FOV: 45 degrees · modified Davis grading · NIDEK AFC-230 fundus camera
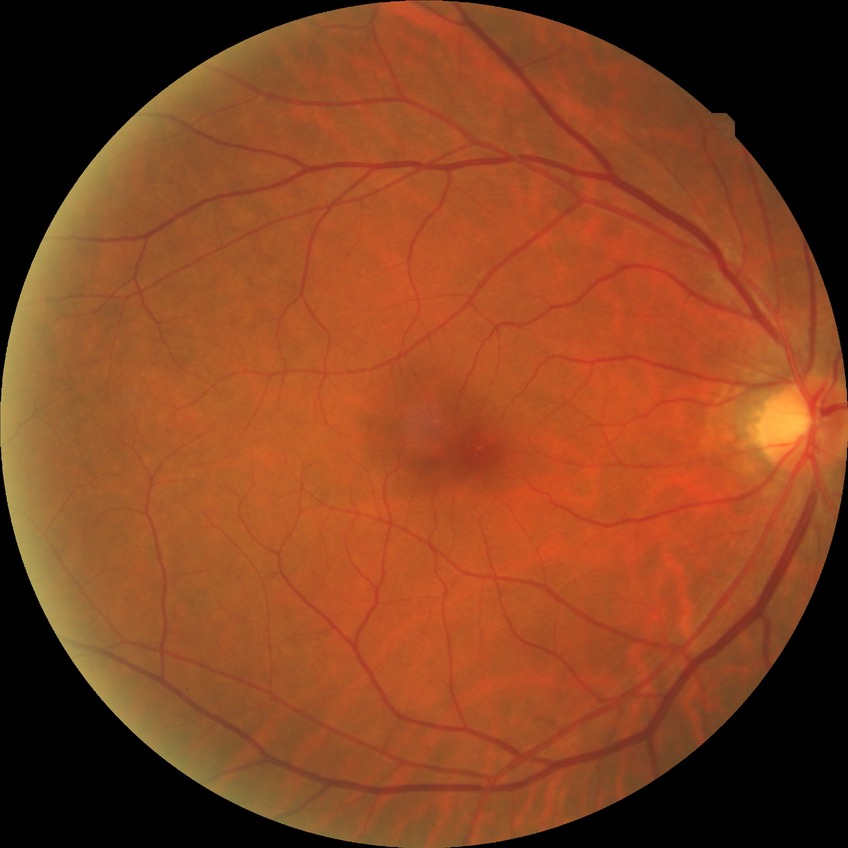

Retinopathy stage: no diabetic retinopathy.